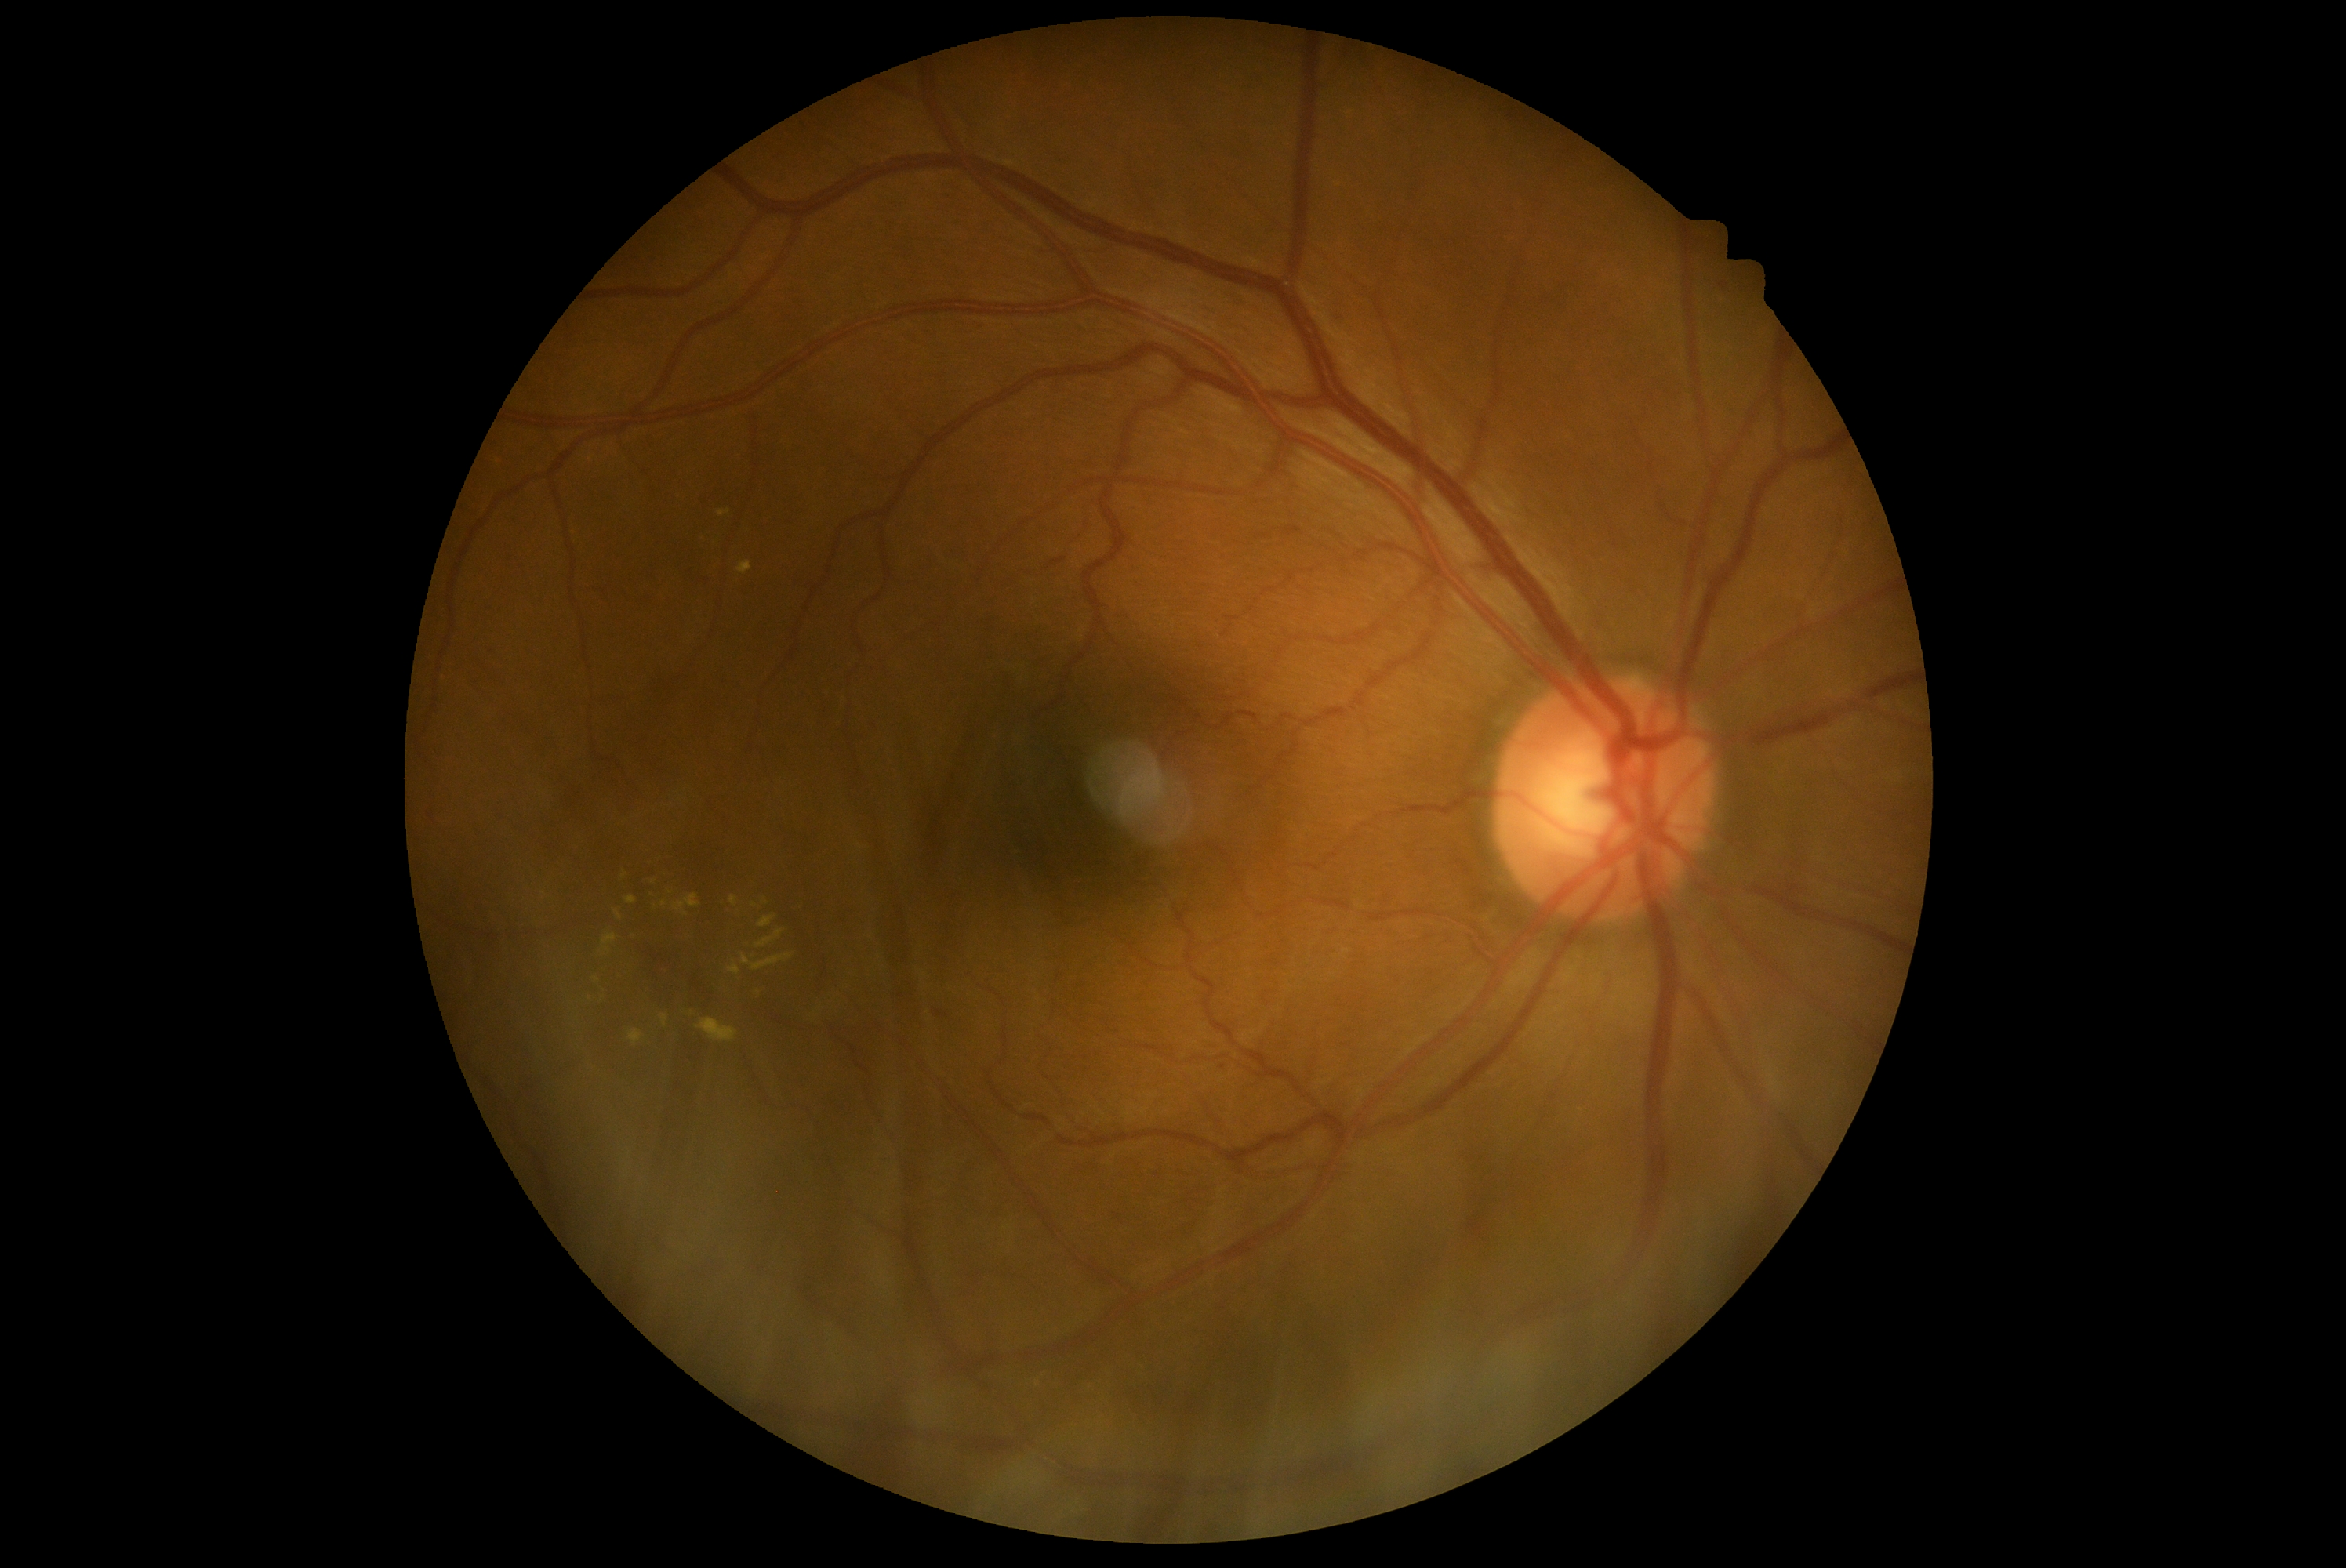
Diabetic retinopathy (DR) is grade 2 — more than just microaneurysms but less than severe NPDR.